Modified Davis grading · 45 degree fundus photograph · NIDEK AFC-230 fundus camera · nonmydriatic fundus photograph · fundus photo — 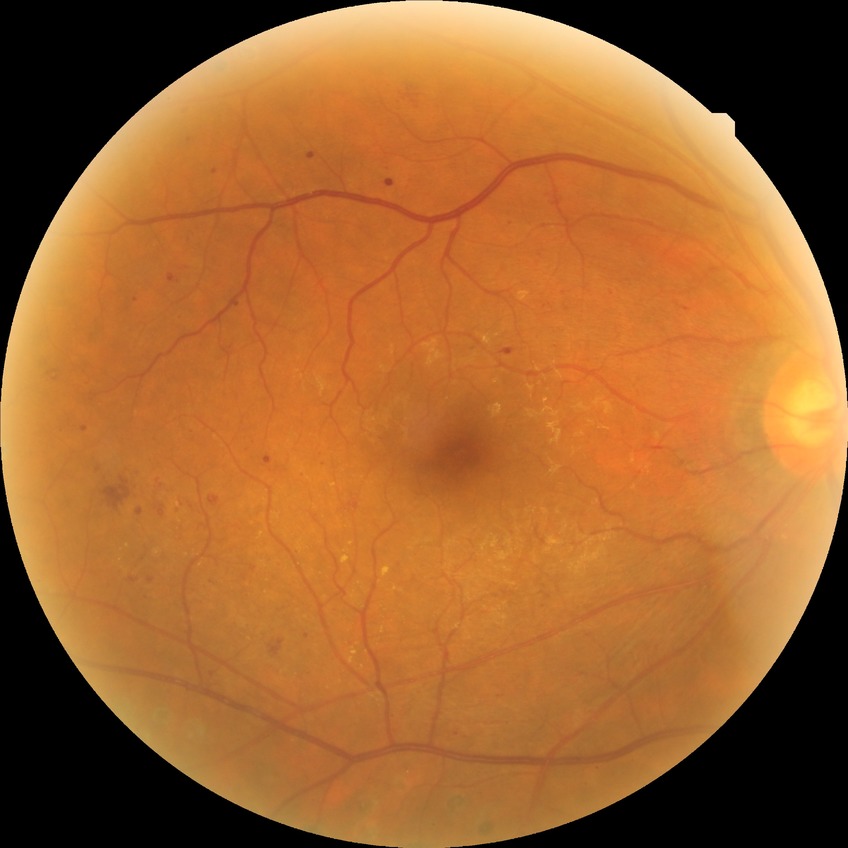 {
  "davis_grade": "PDR (proliferative diabetic retinopathy)"
}